Image size 848x848. Acquired with a NIDEK AFC-230
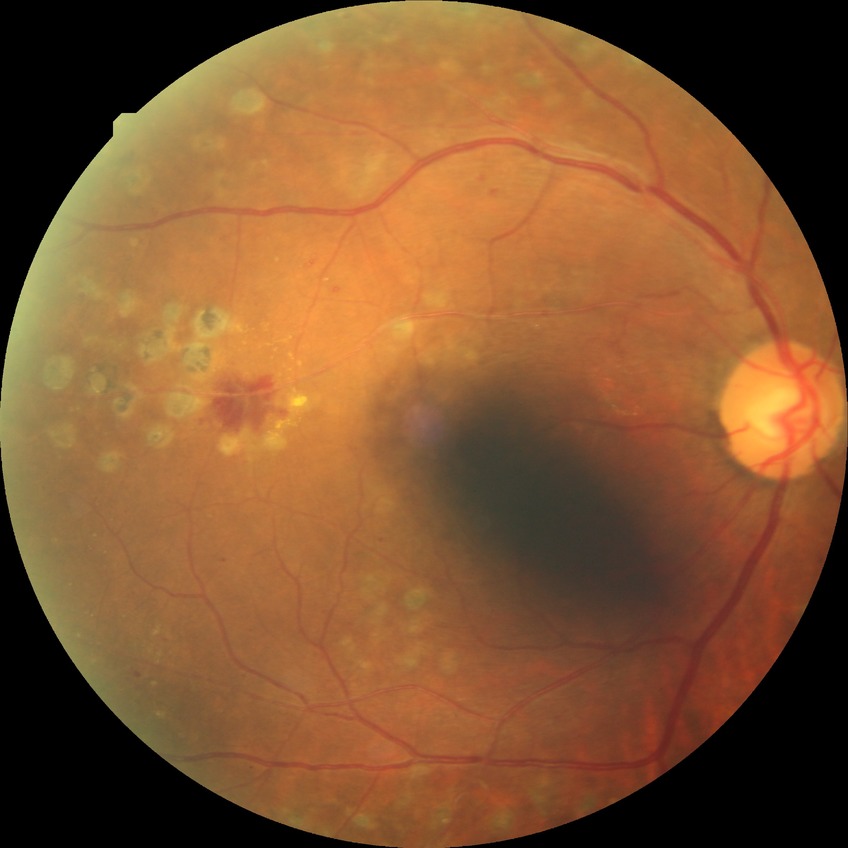

Davis stage is PDR.